Pediatric retinal photograph (wide-field). 130° field of view (Clarity RetCam 3).
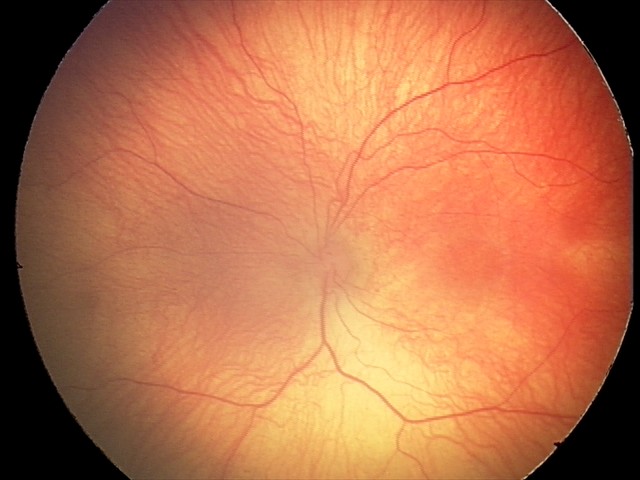
Plus disease absent.
Examination diagnosed as ROP stage 2.